Camera: Topcon TRC-NW8
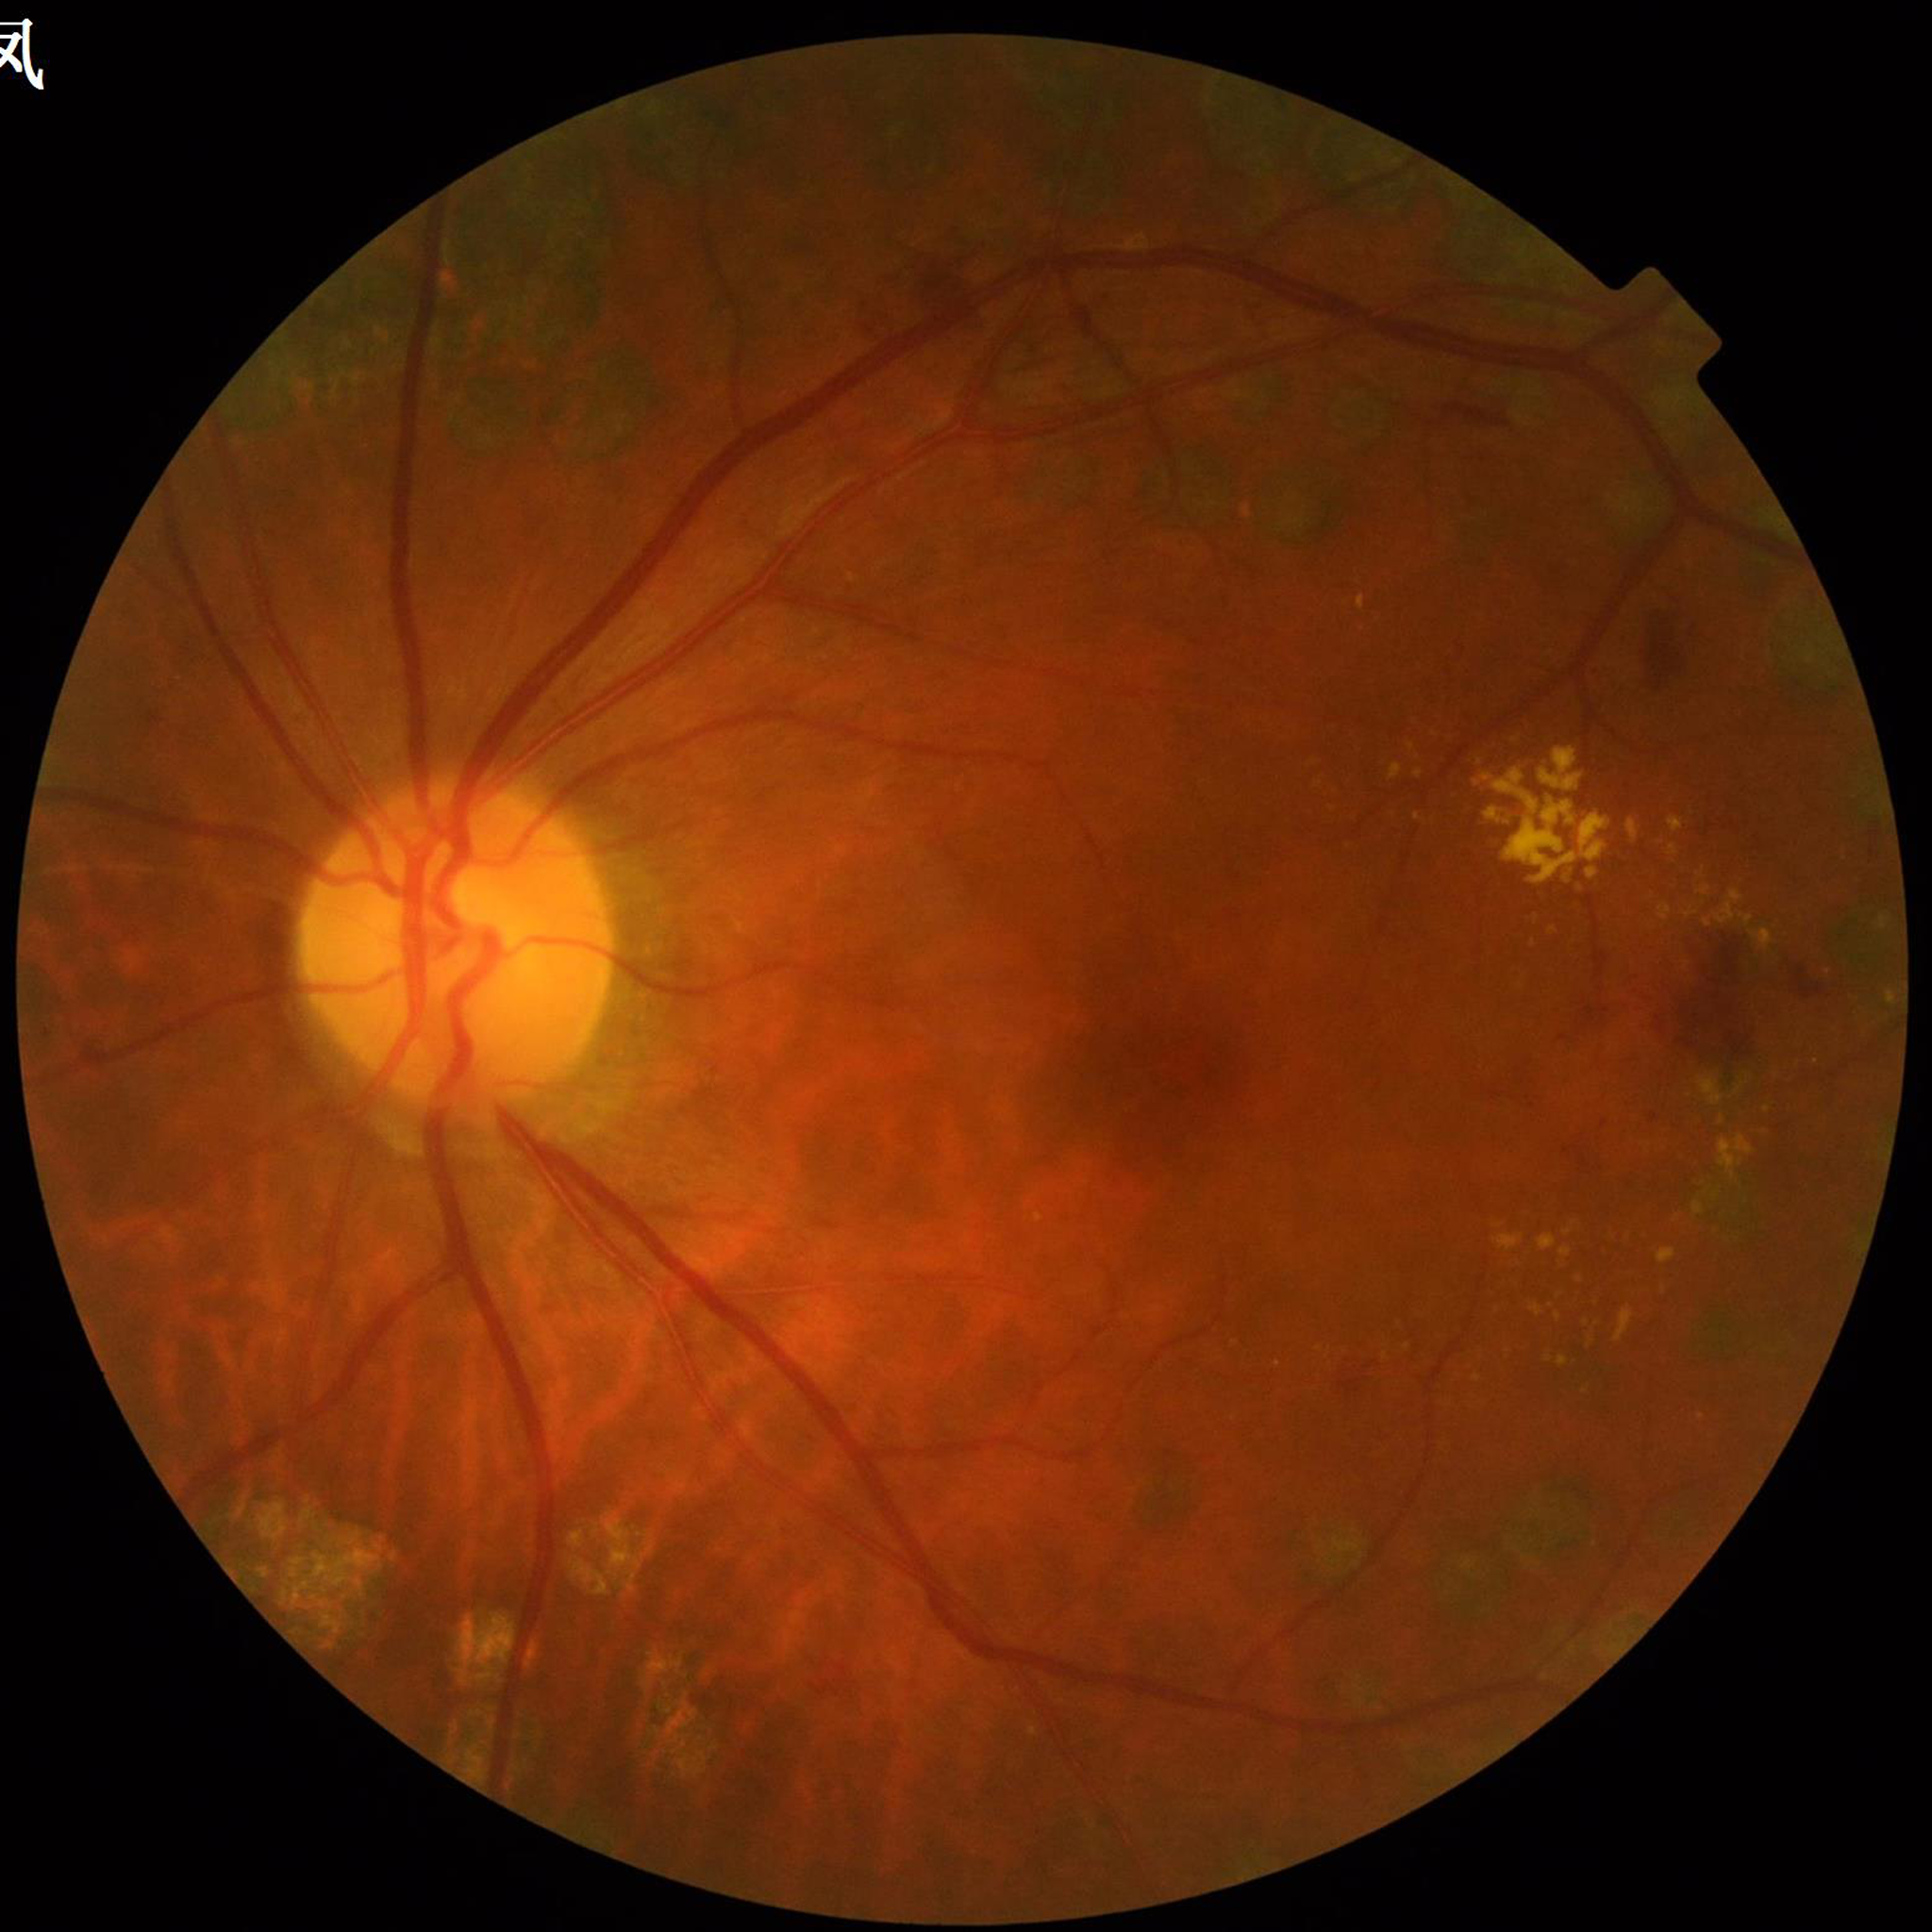 {
  "diagnosis": "diabetic retinopathy (DR)",
  "image_quality": "no quality issues identified"
}